NIDEK AFC-230. 45° FOV
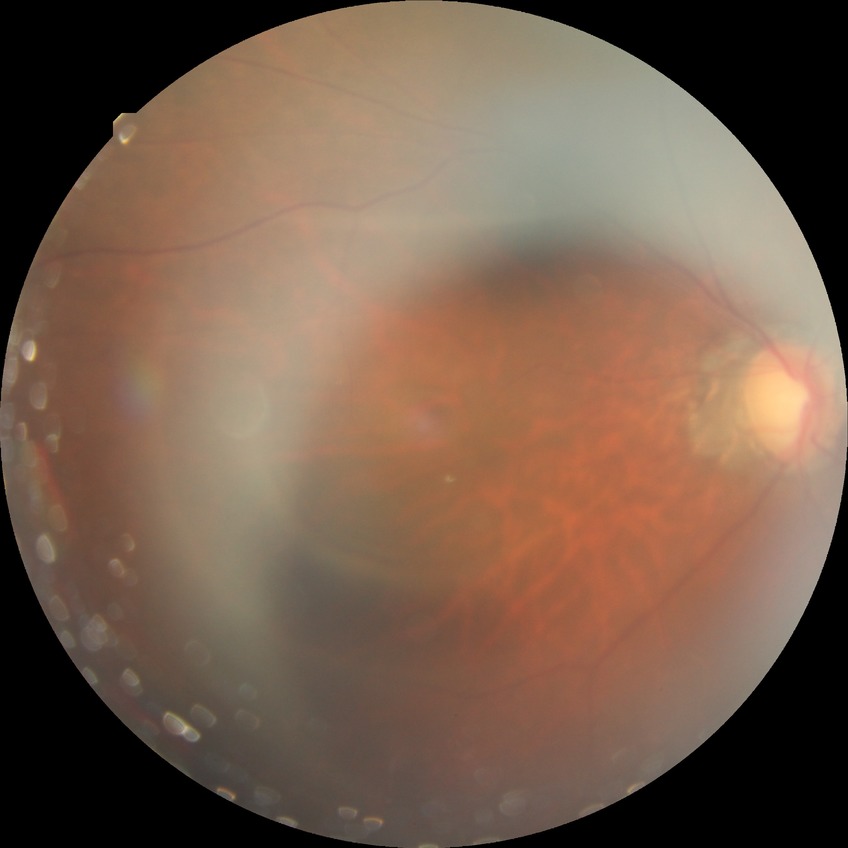 Assessment:
• DR impression — no apparent DR
• Davis stage — NDR